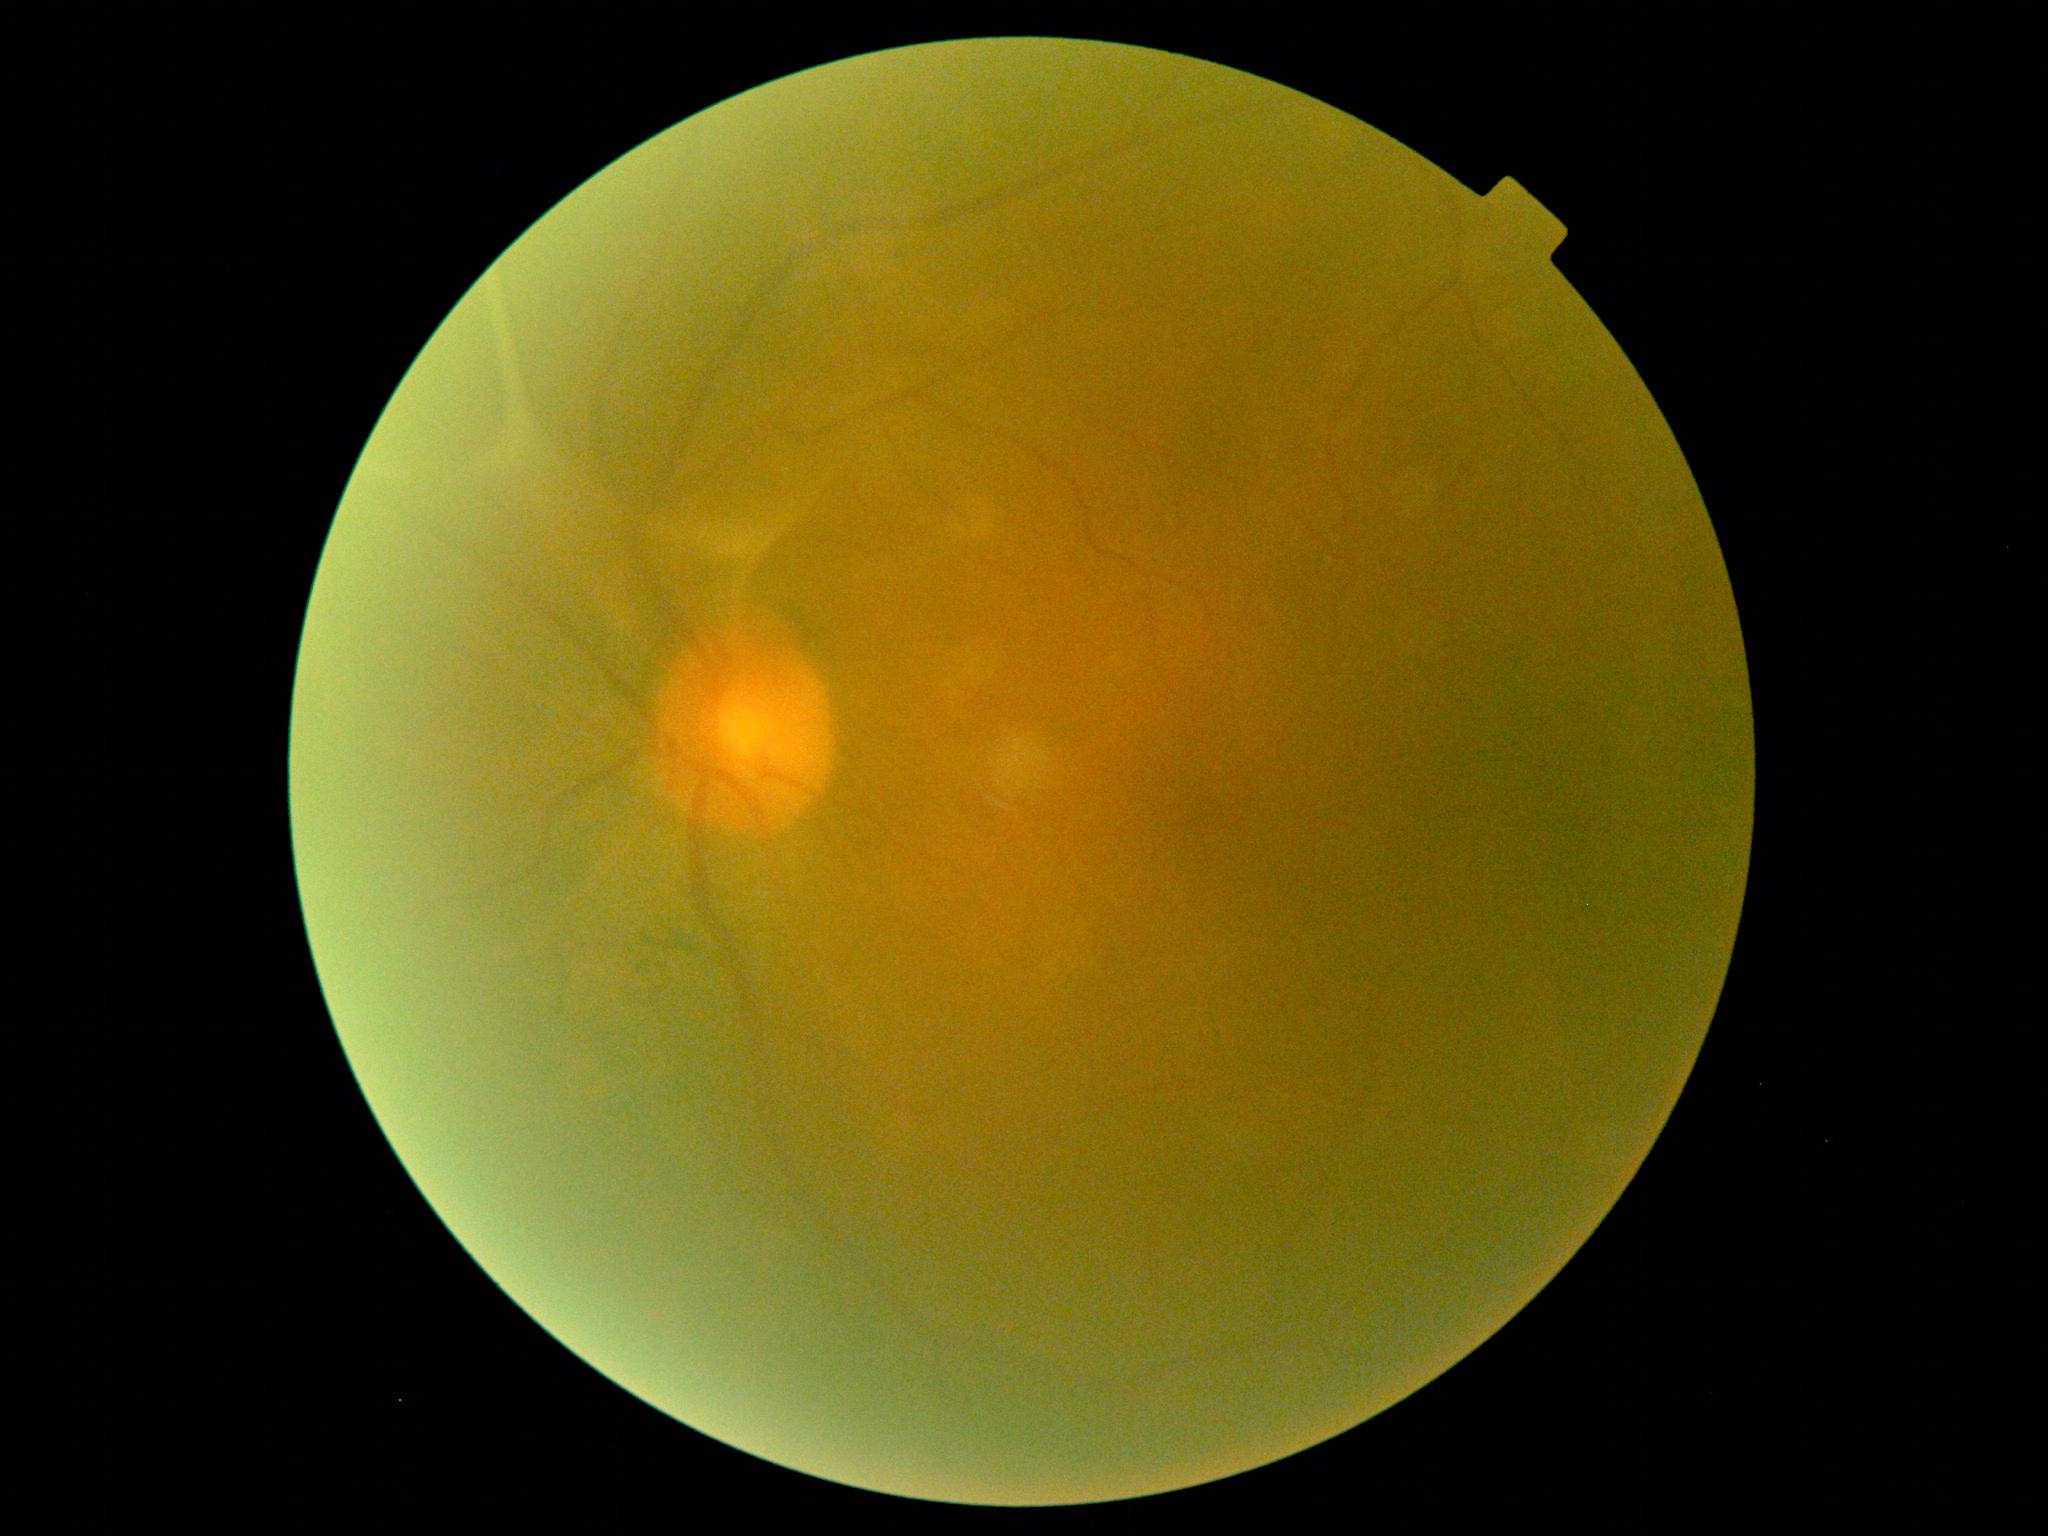
DR severity: PDR (grade 4).